Fundus photo · image size 2212x1659: 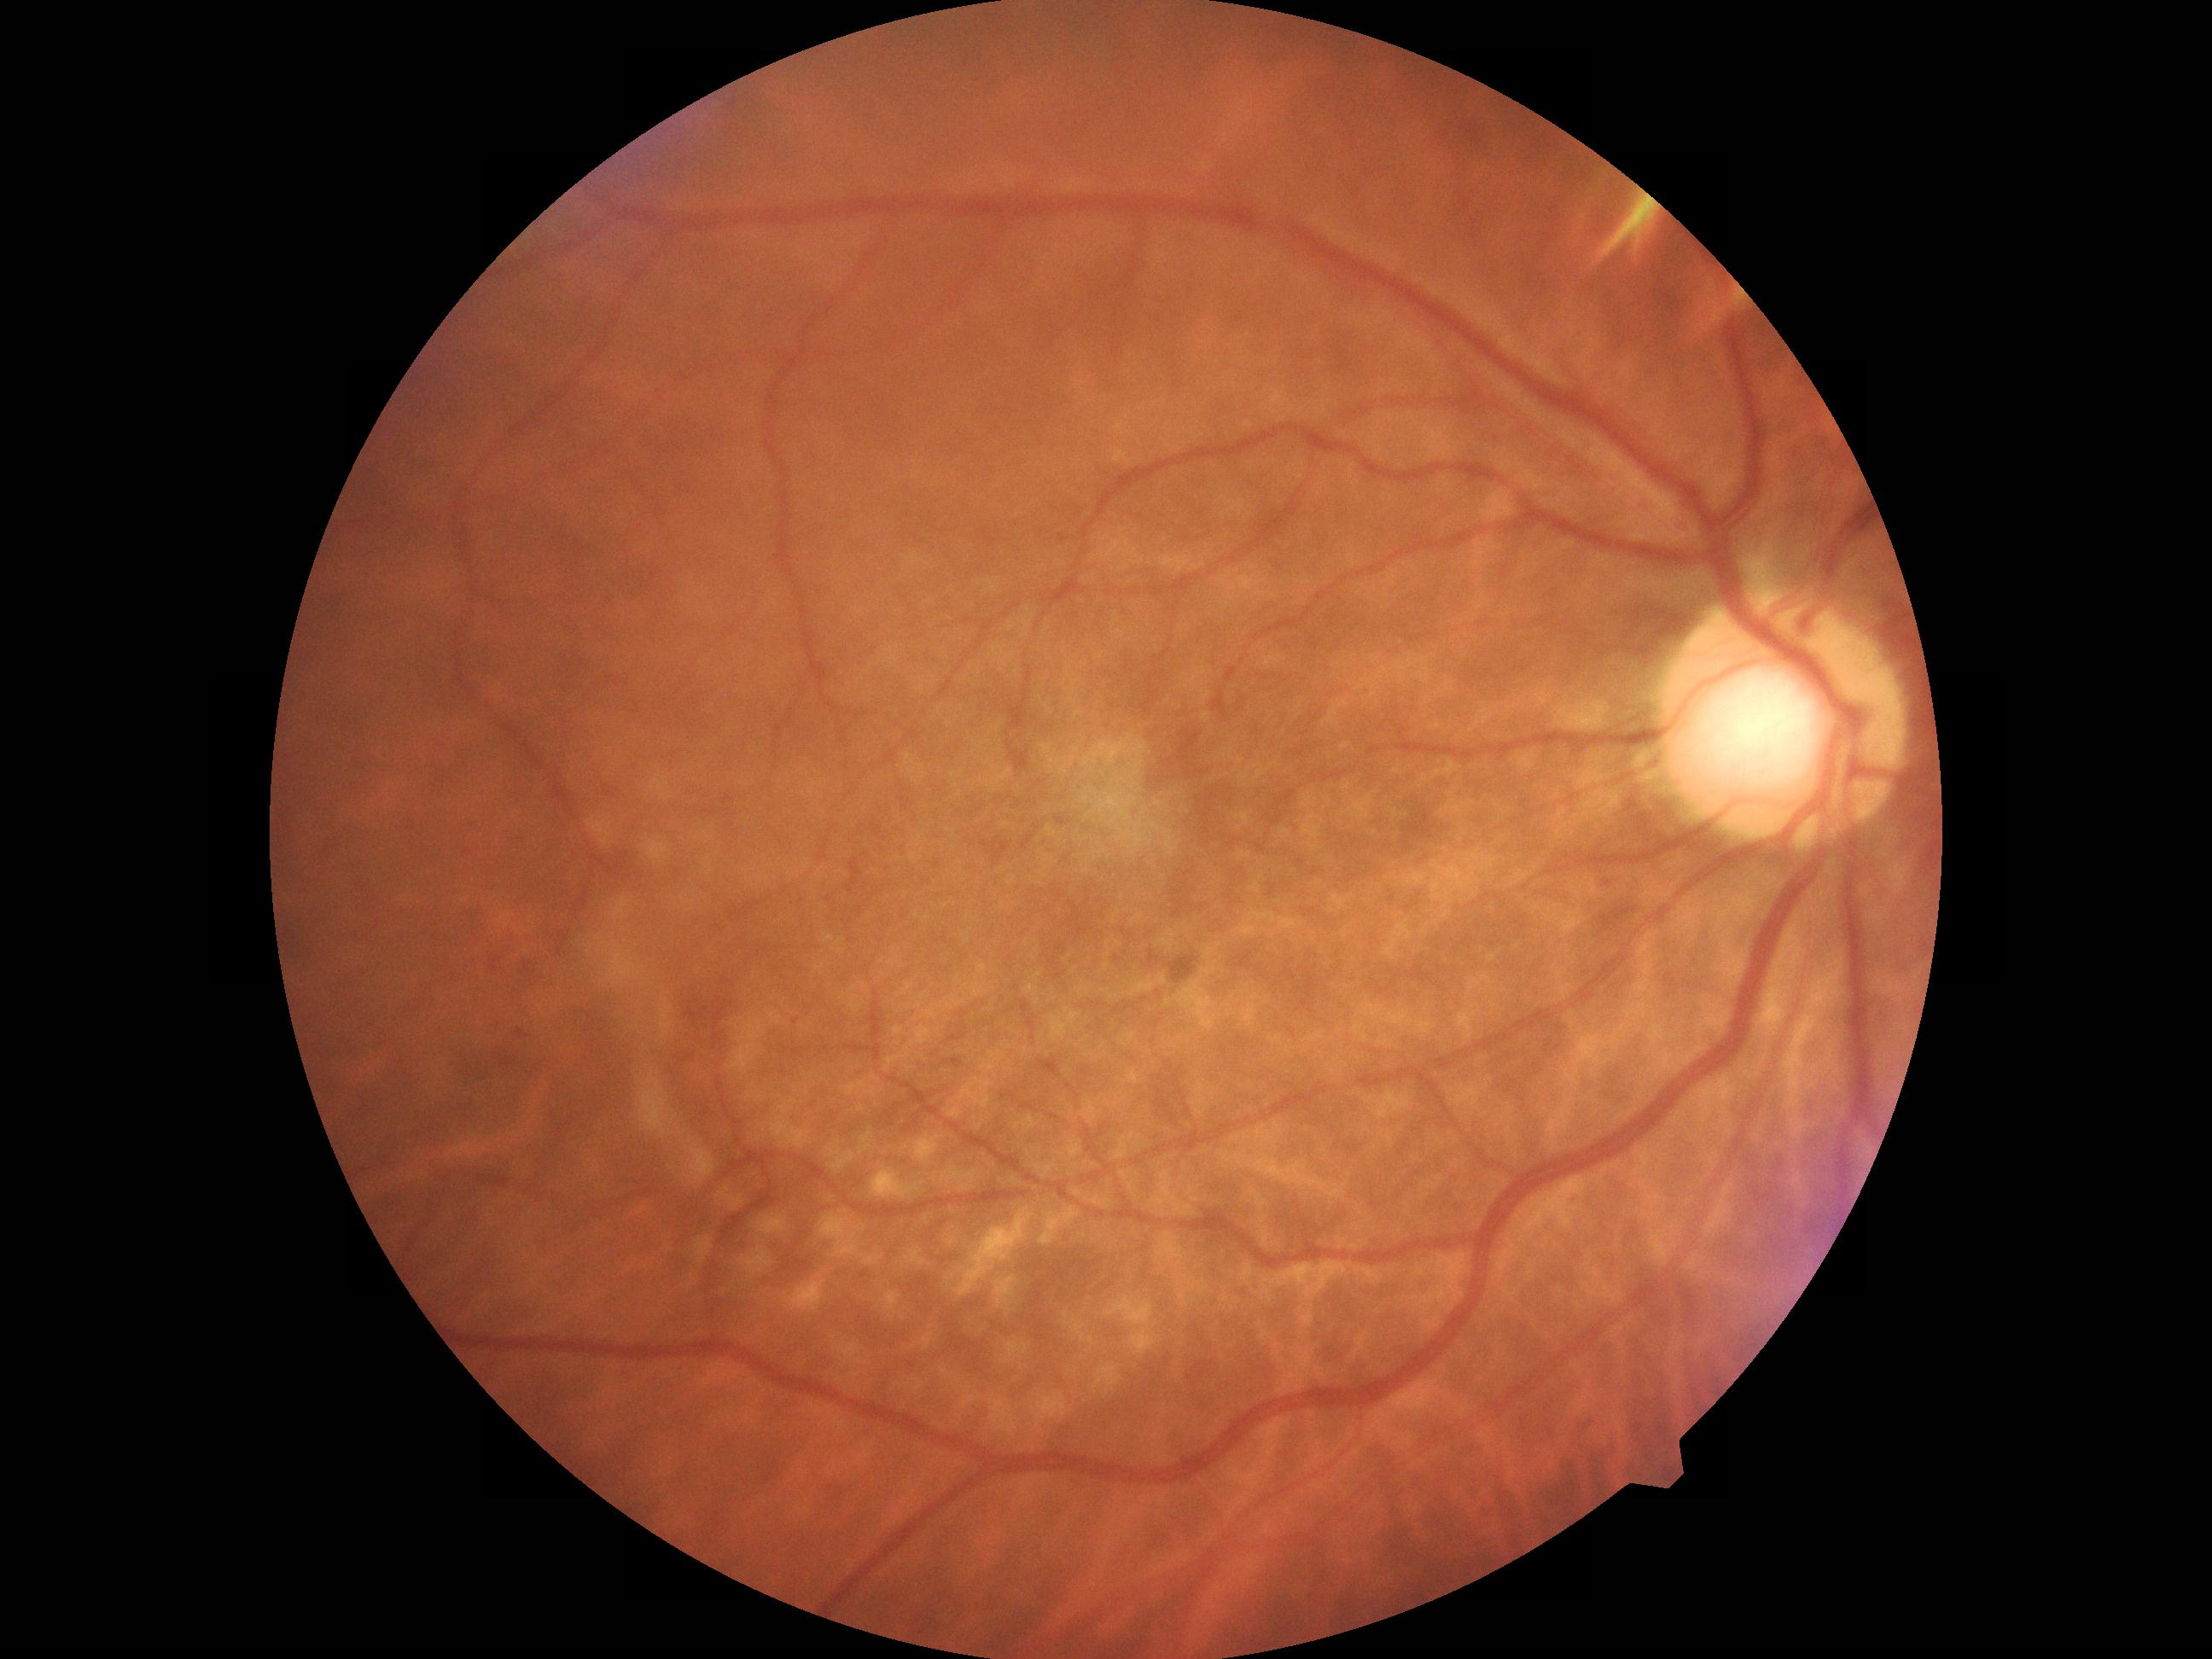 DR: grade 1 (mild NPDR).
DR class: non-proliferative diabetic retinopathy.